949x949px; optic disc-centered crop from a color fundus photograph: 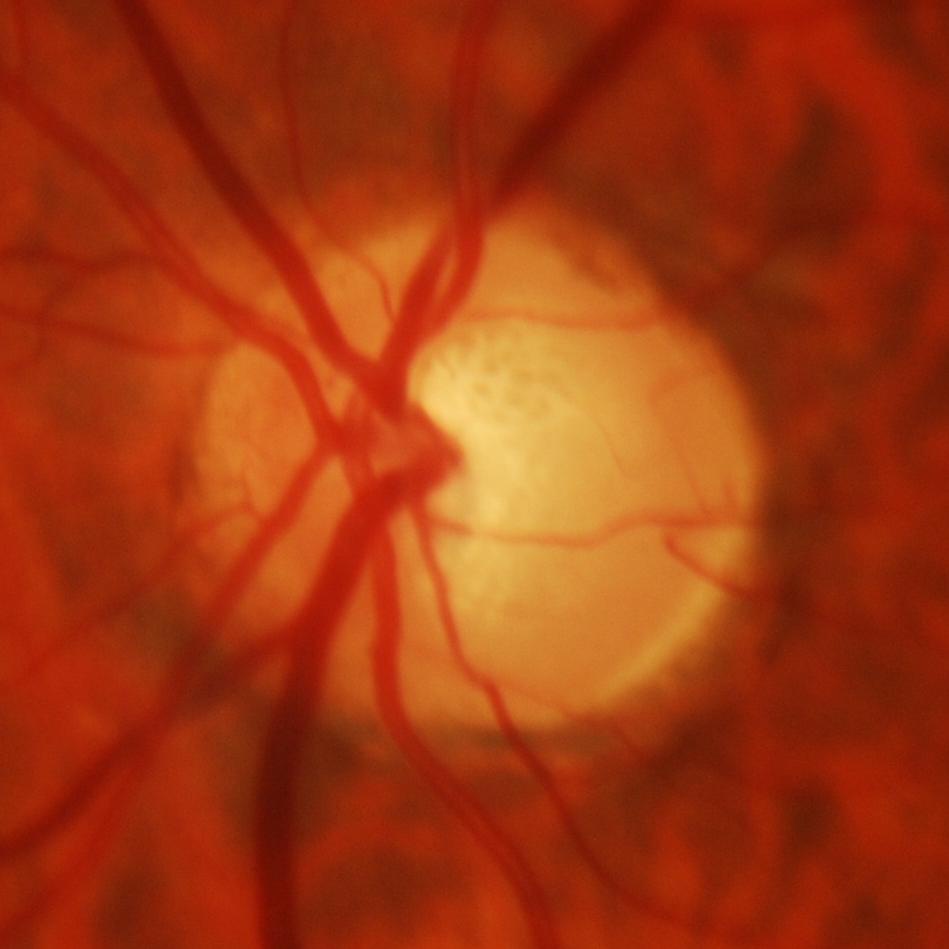
Q: Is glaucoma present?
A: Glaucomatous damage to the optic nerve.